Graded on the modified Davis scale — 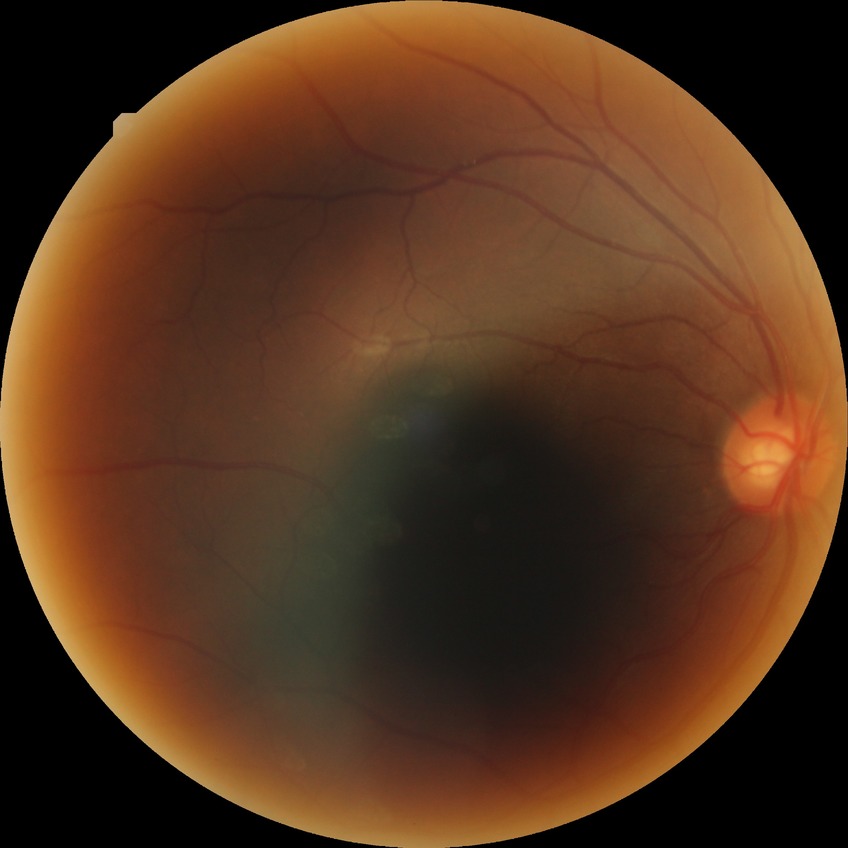

Diabetic retinopathy (DR) is no diabetic retinopathy (NDR).